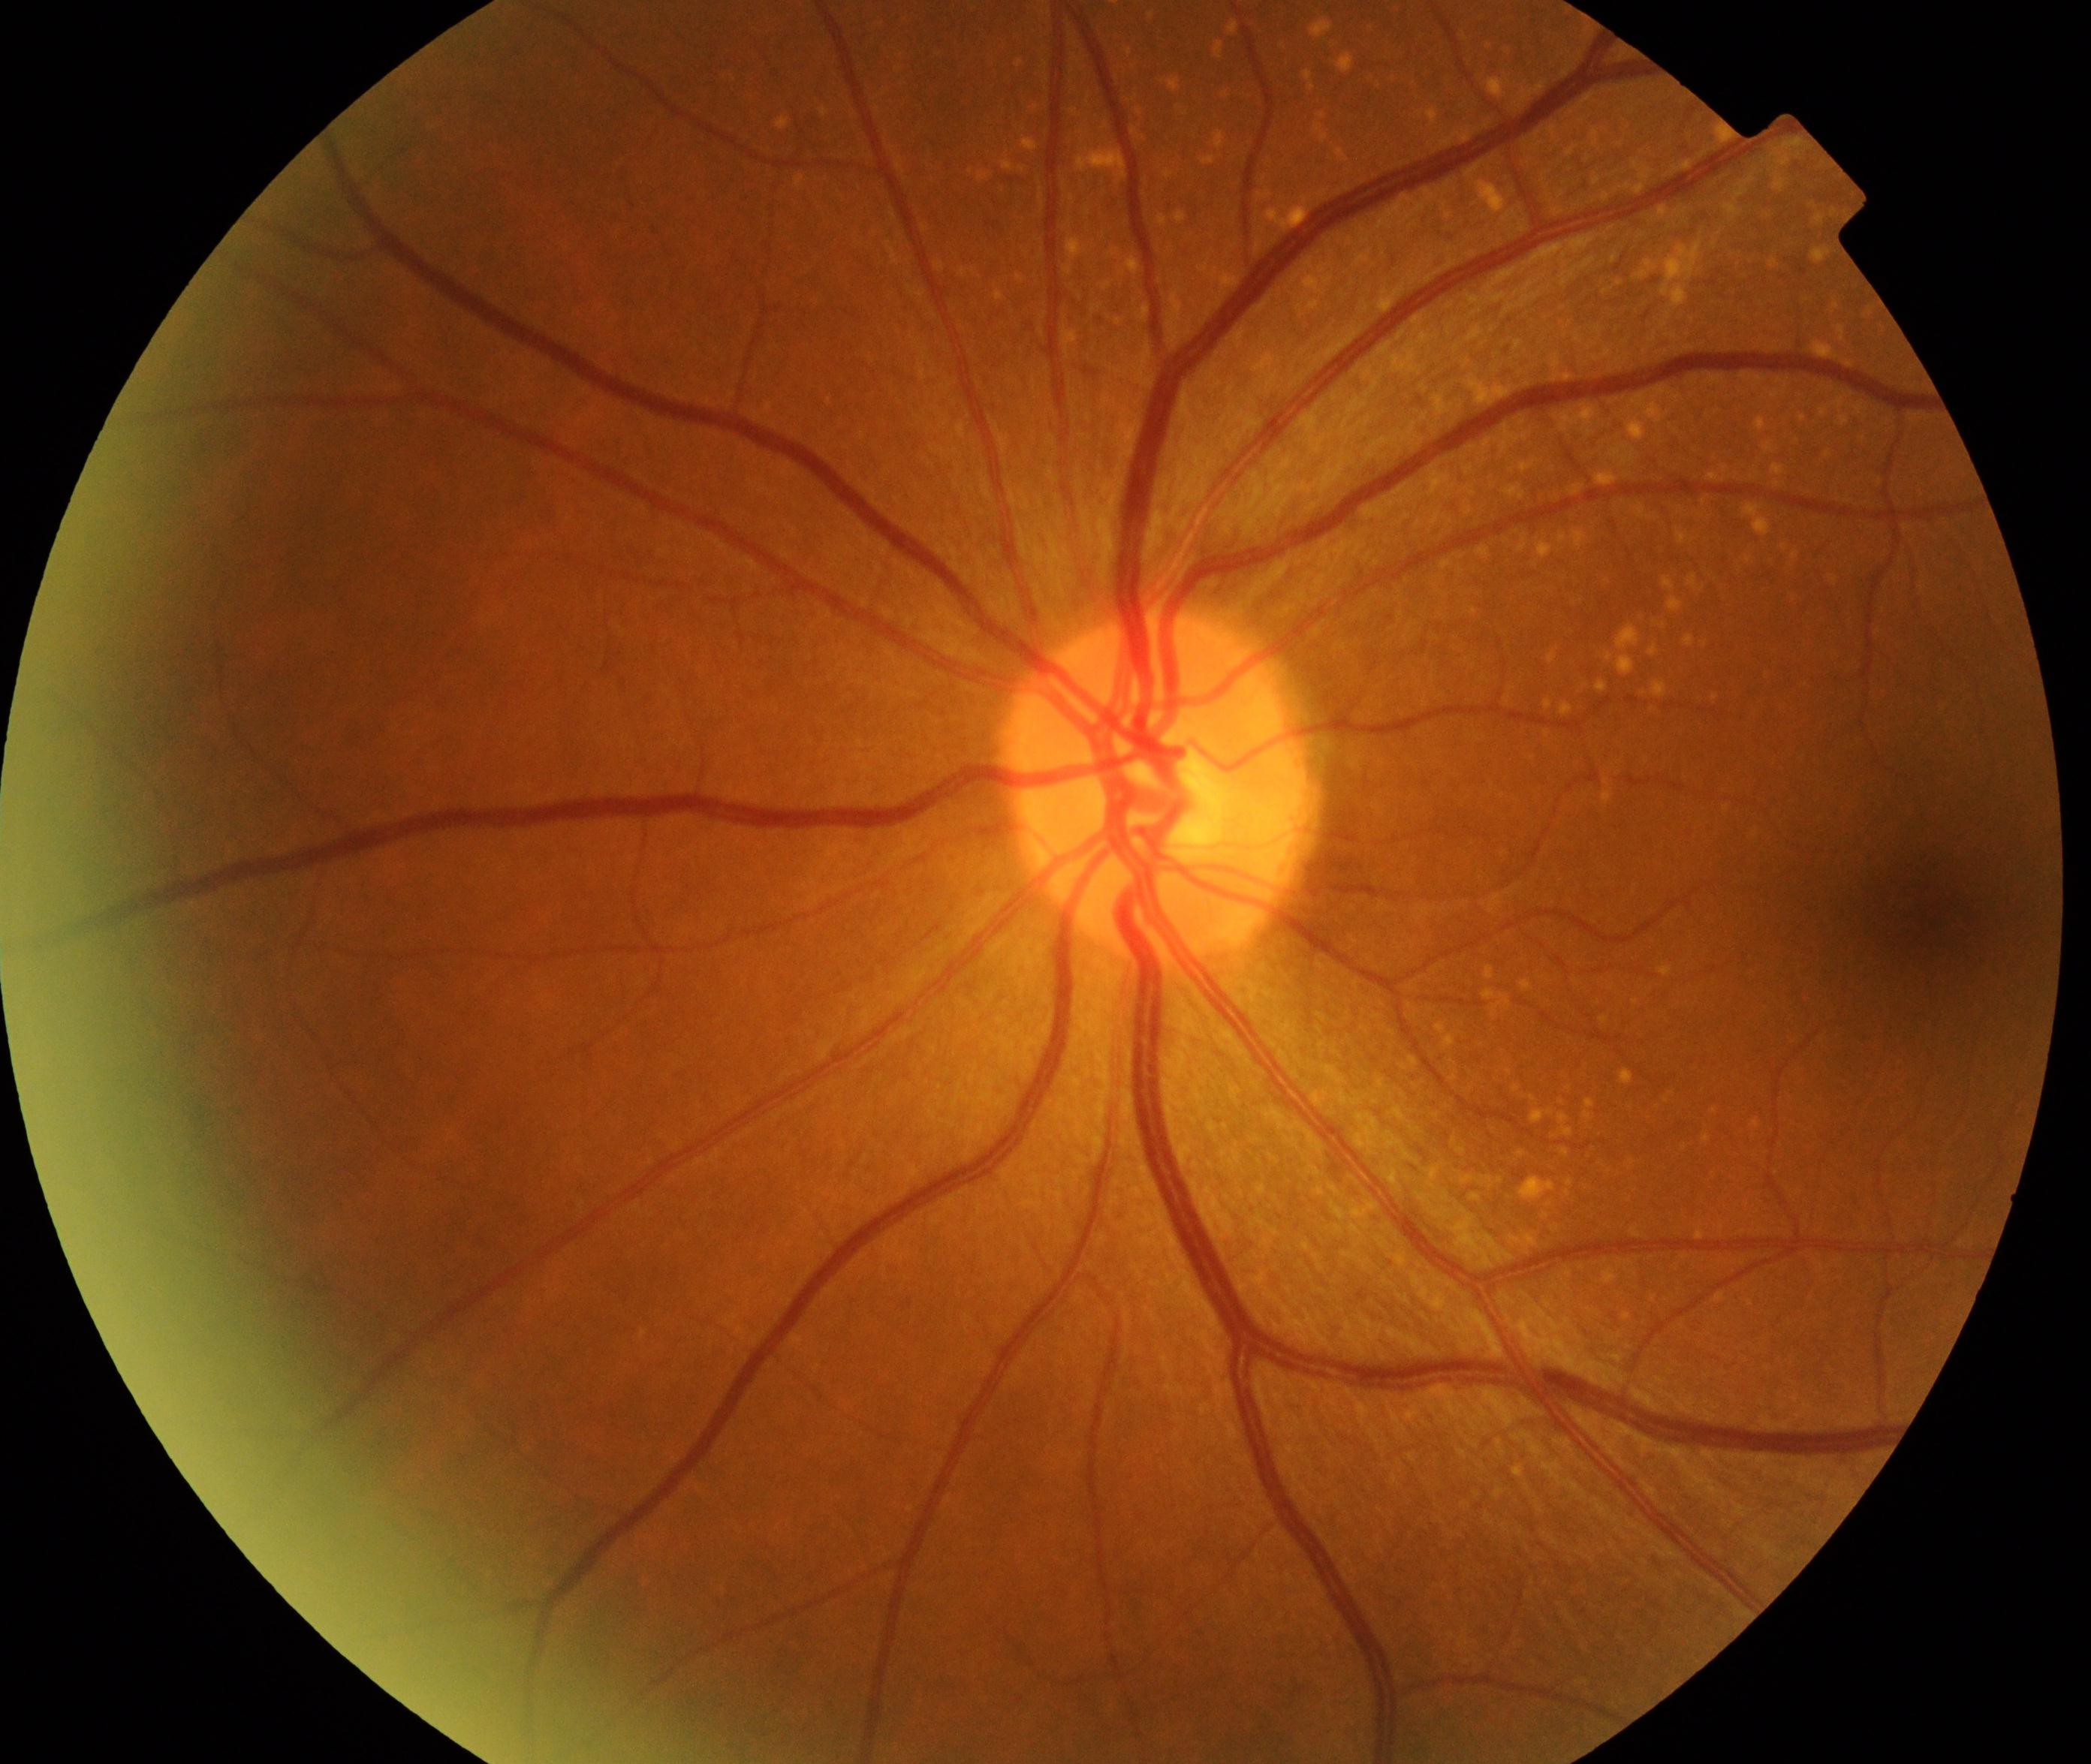 Retinal fundus photograph demonstrating yellow-white spots or flecks.